Retinal fundus photograph.
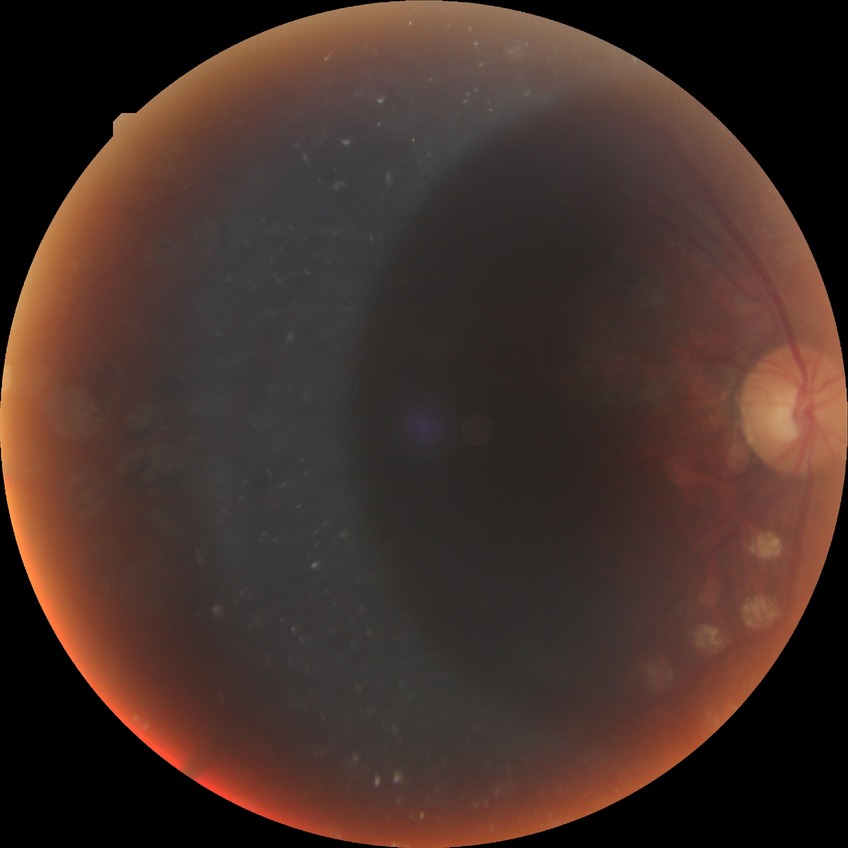 diabetic retinopathy (DR) = proliferative diabetic retinopathy (PDR).